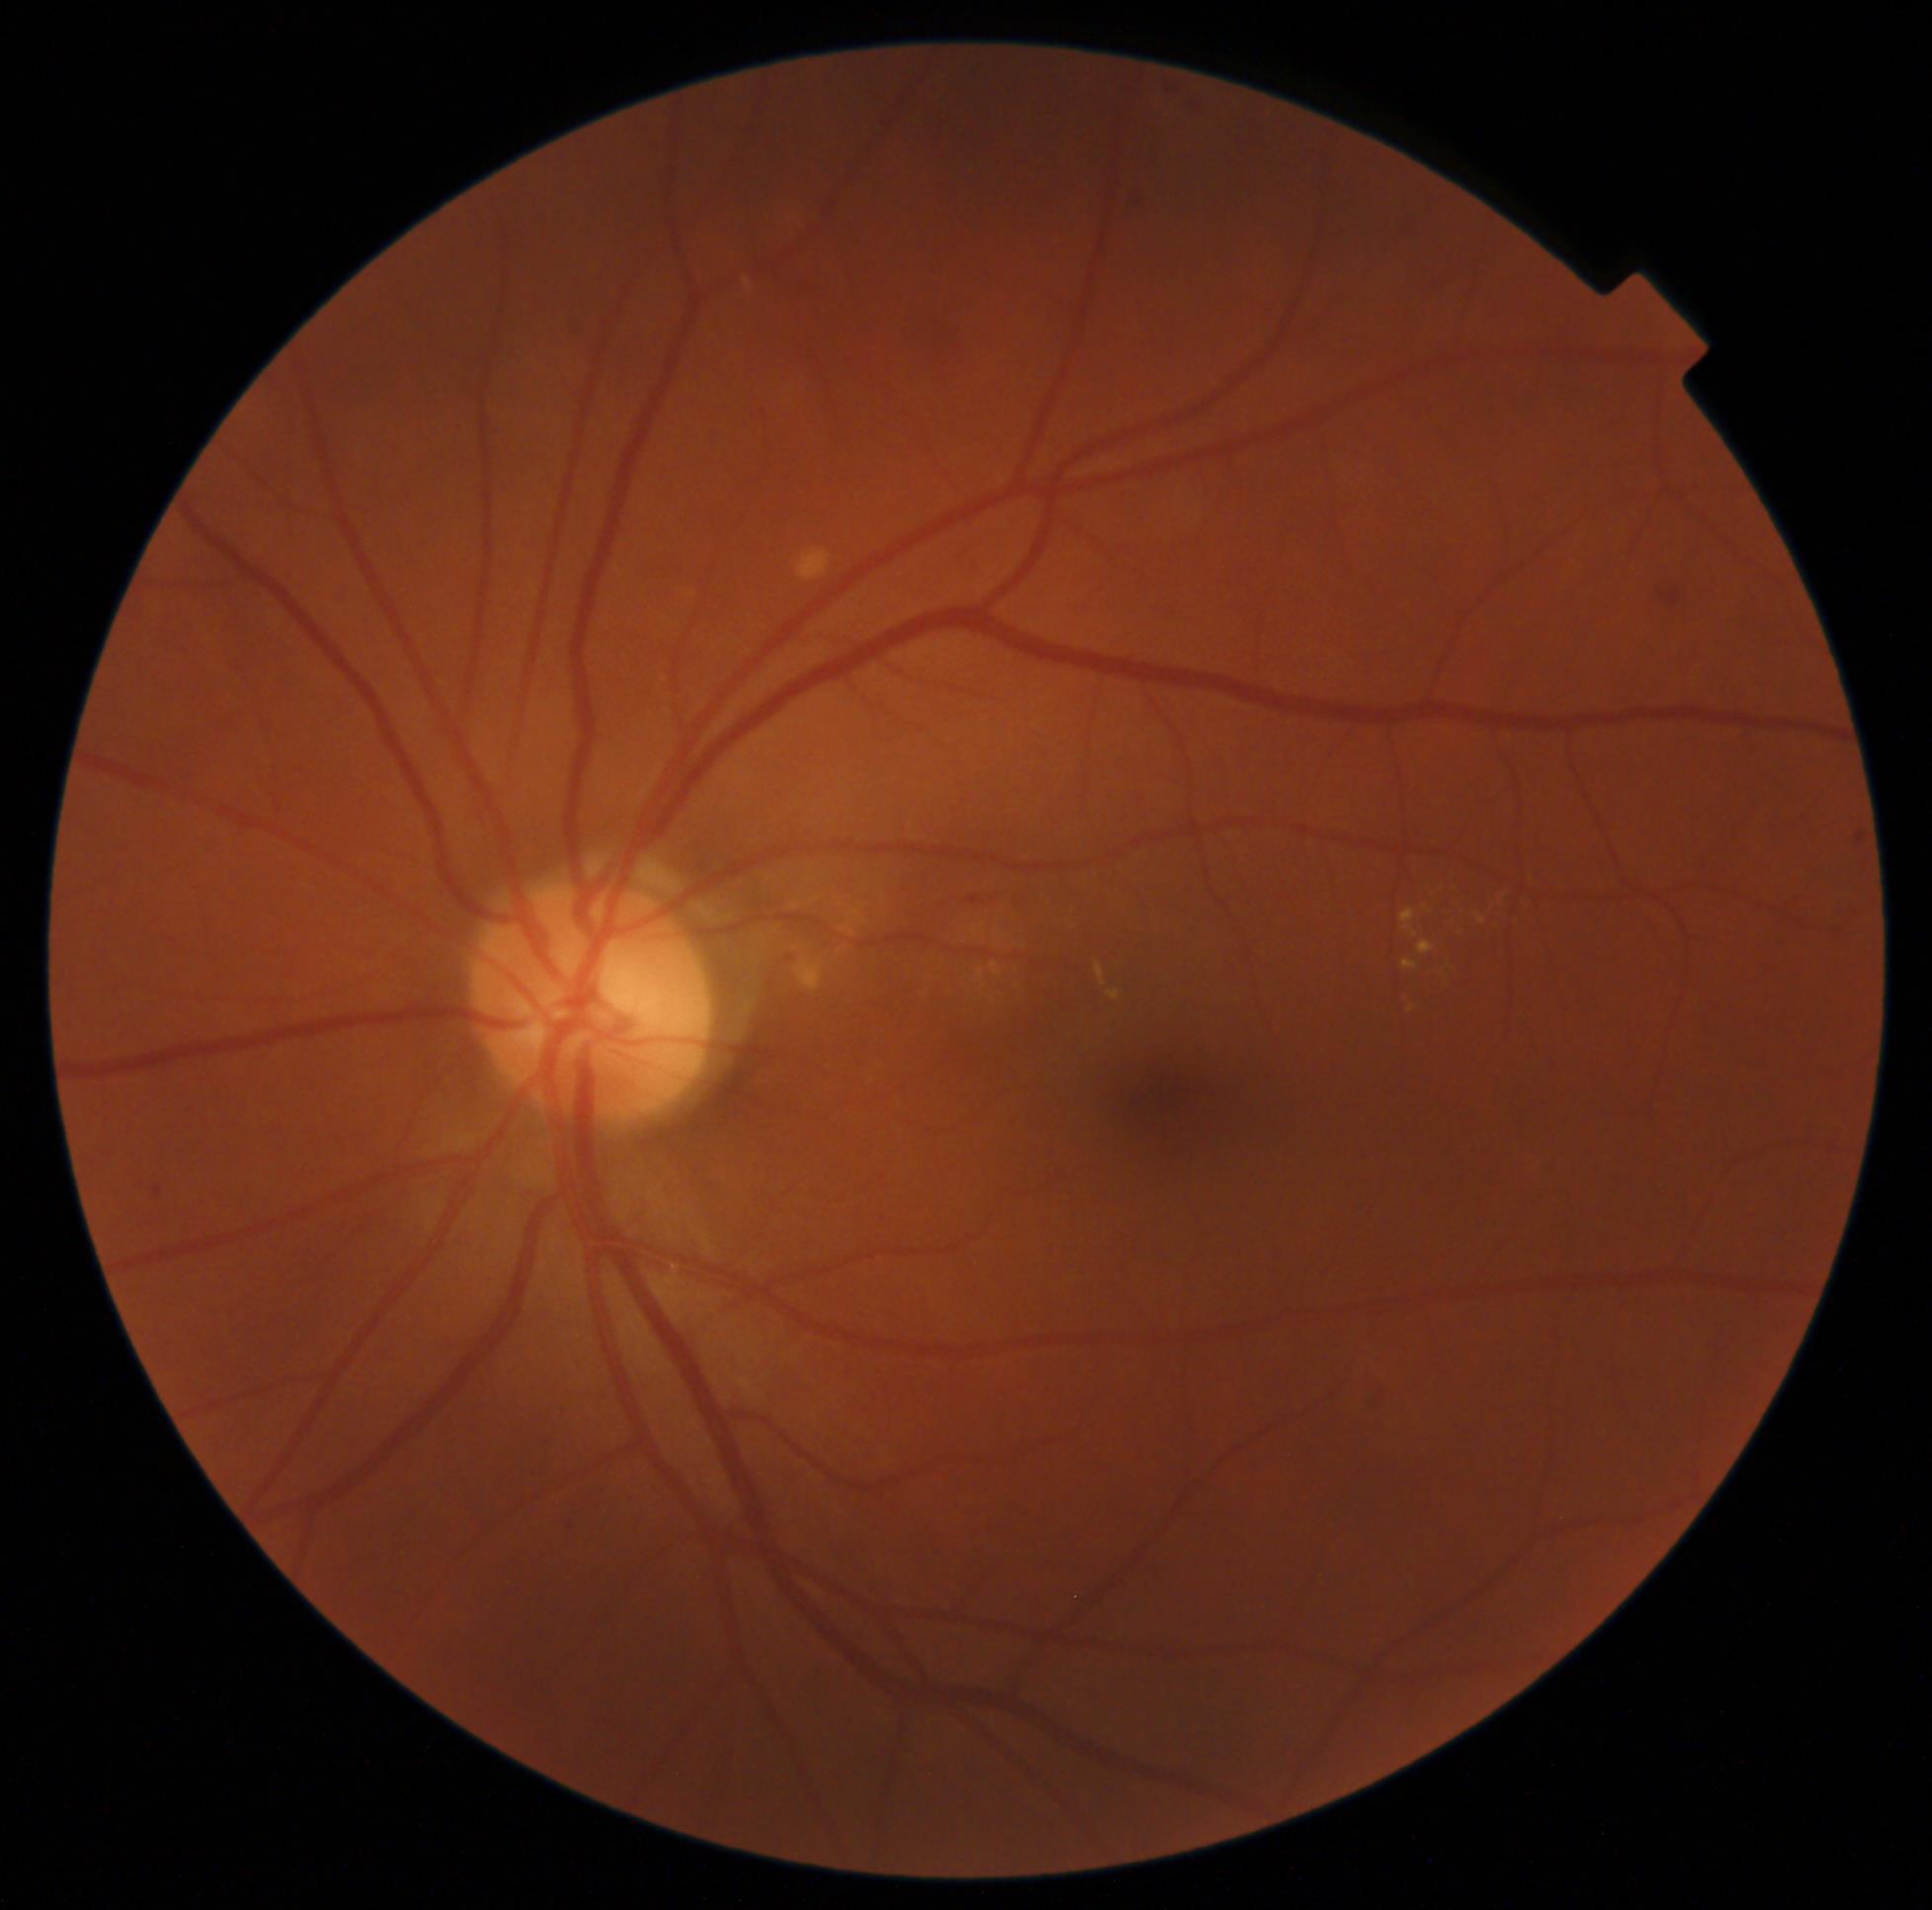 dr_grade: 2
dr_grade_name: moderate NPDR
lesions:
  ma:
    - 154,1186,162,1197
  ex:
    - 1401,908,1418,938
    - 1409,1004,1415,1013
    - 1477,914,1488,925
    - 1108,991,1121,1001
    - 1403,960,1418,971
    - 1095,962,1106,987
    - 1418,940,1436,956
  ex_small:
    - {"x": 1505, "y": 895}
    - {"x": 1425, "y": 908}
  he:
    - 1363,1395,1387,1415
    - 785,954,799,963
    - 577,321,589,343
    - 1663,590,1681,606
  se: []